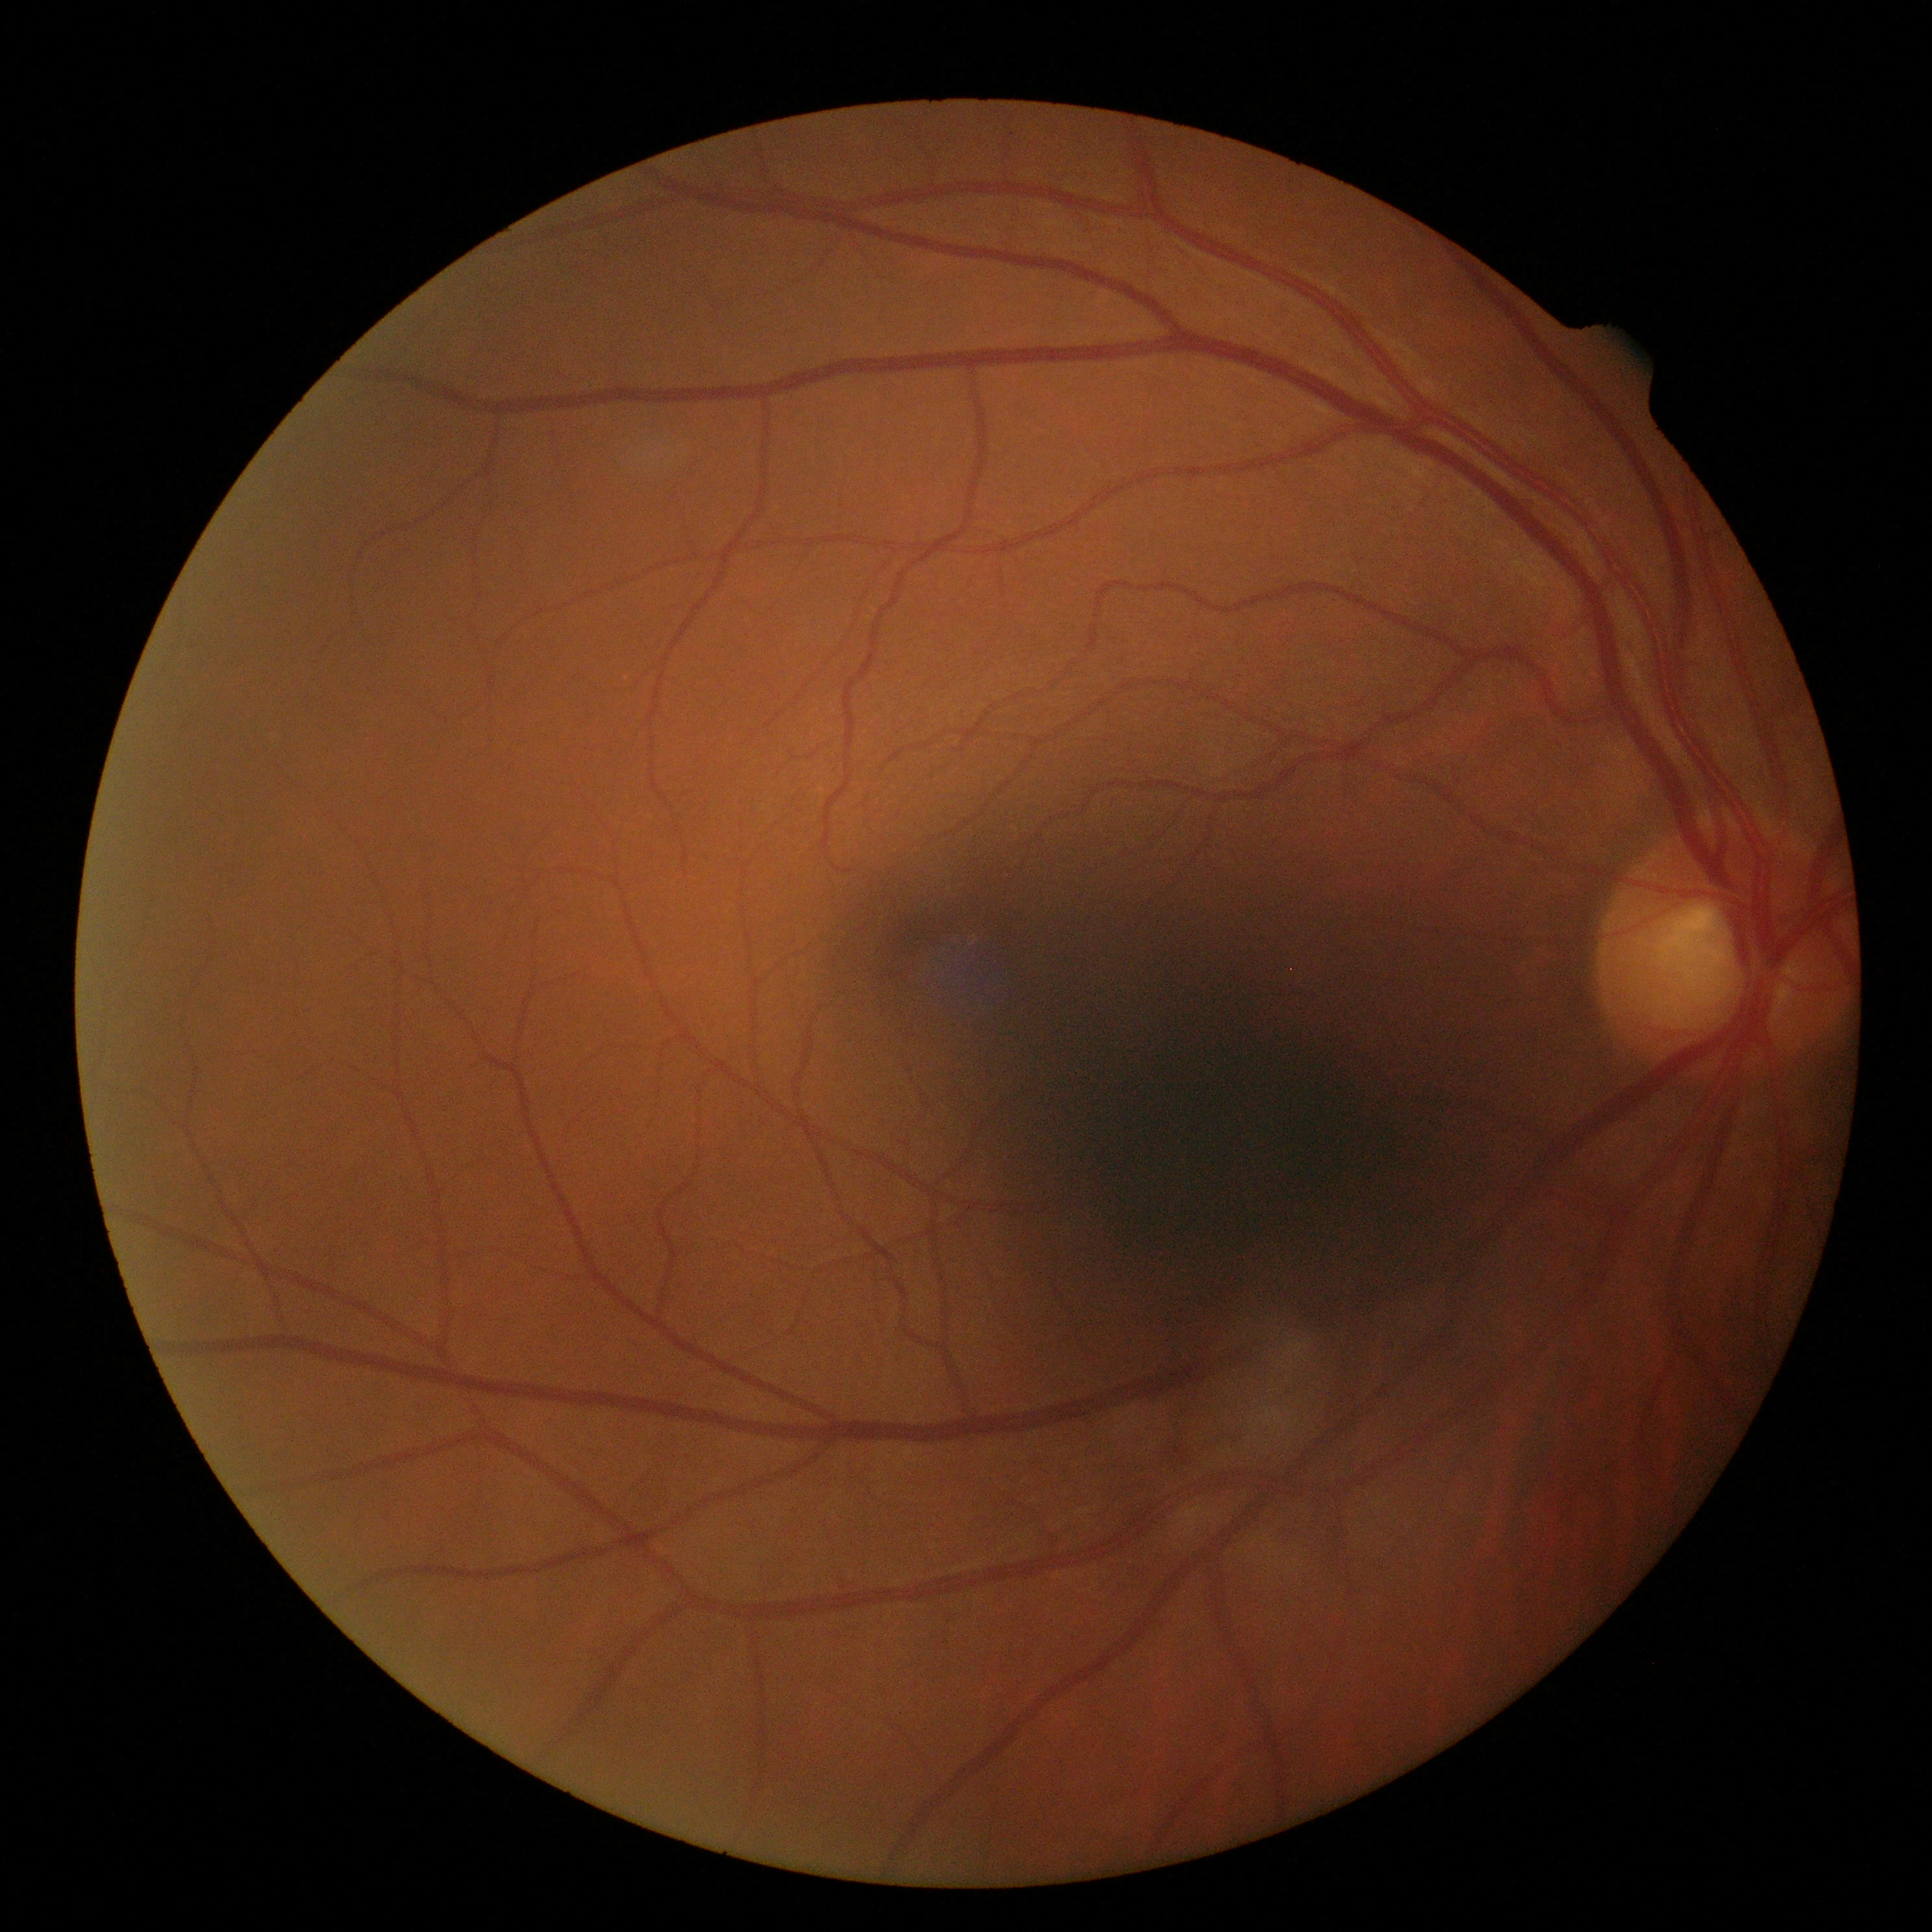
{"dr_grade": "no apparent retinopathy (grade 0)"}